2212 by 1659 pixels; color fundus image: 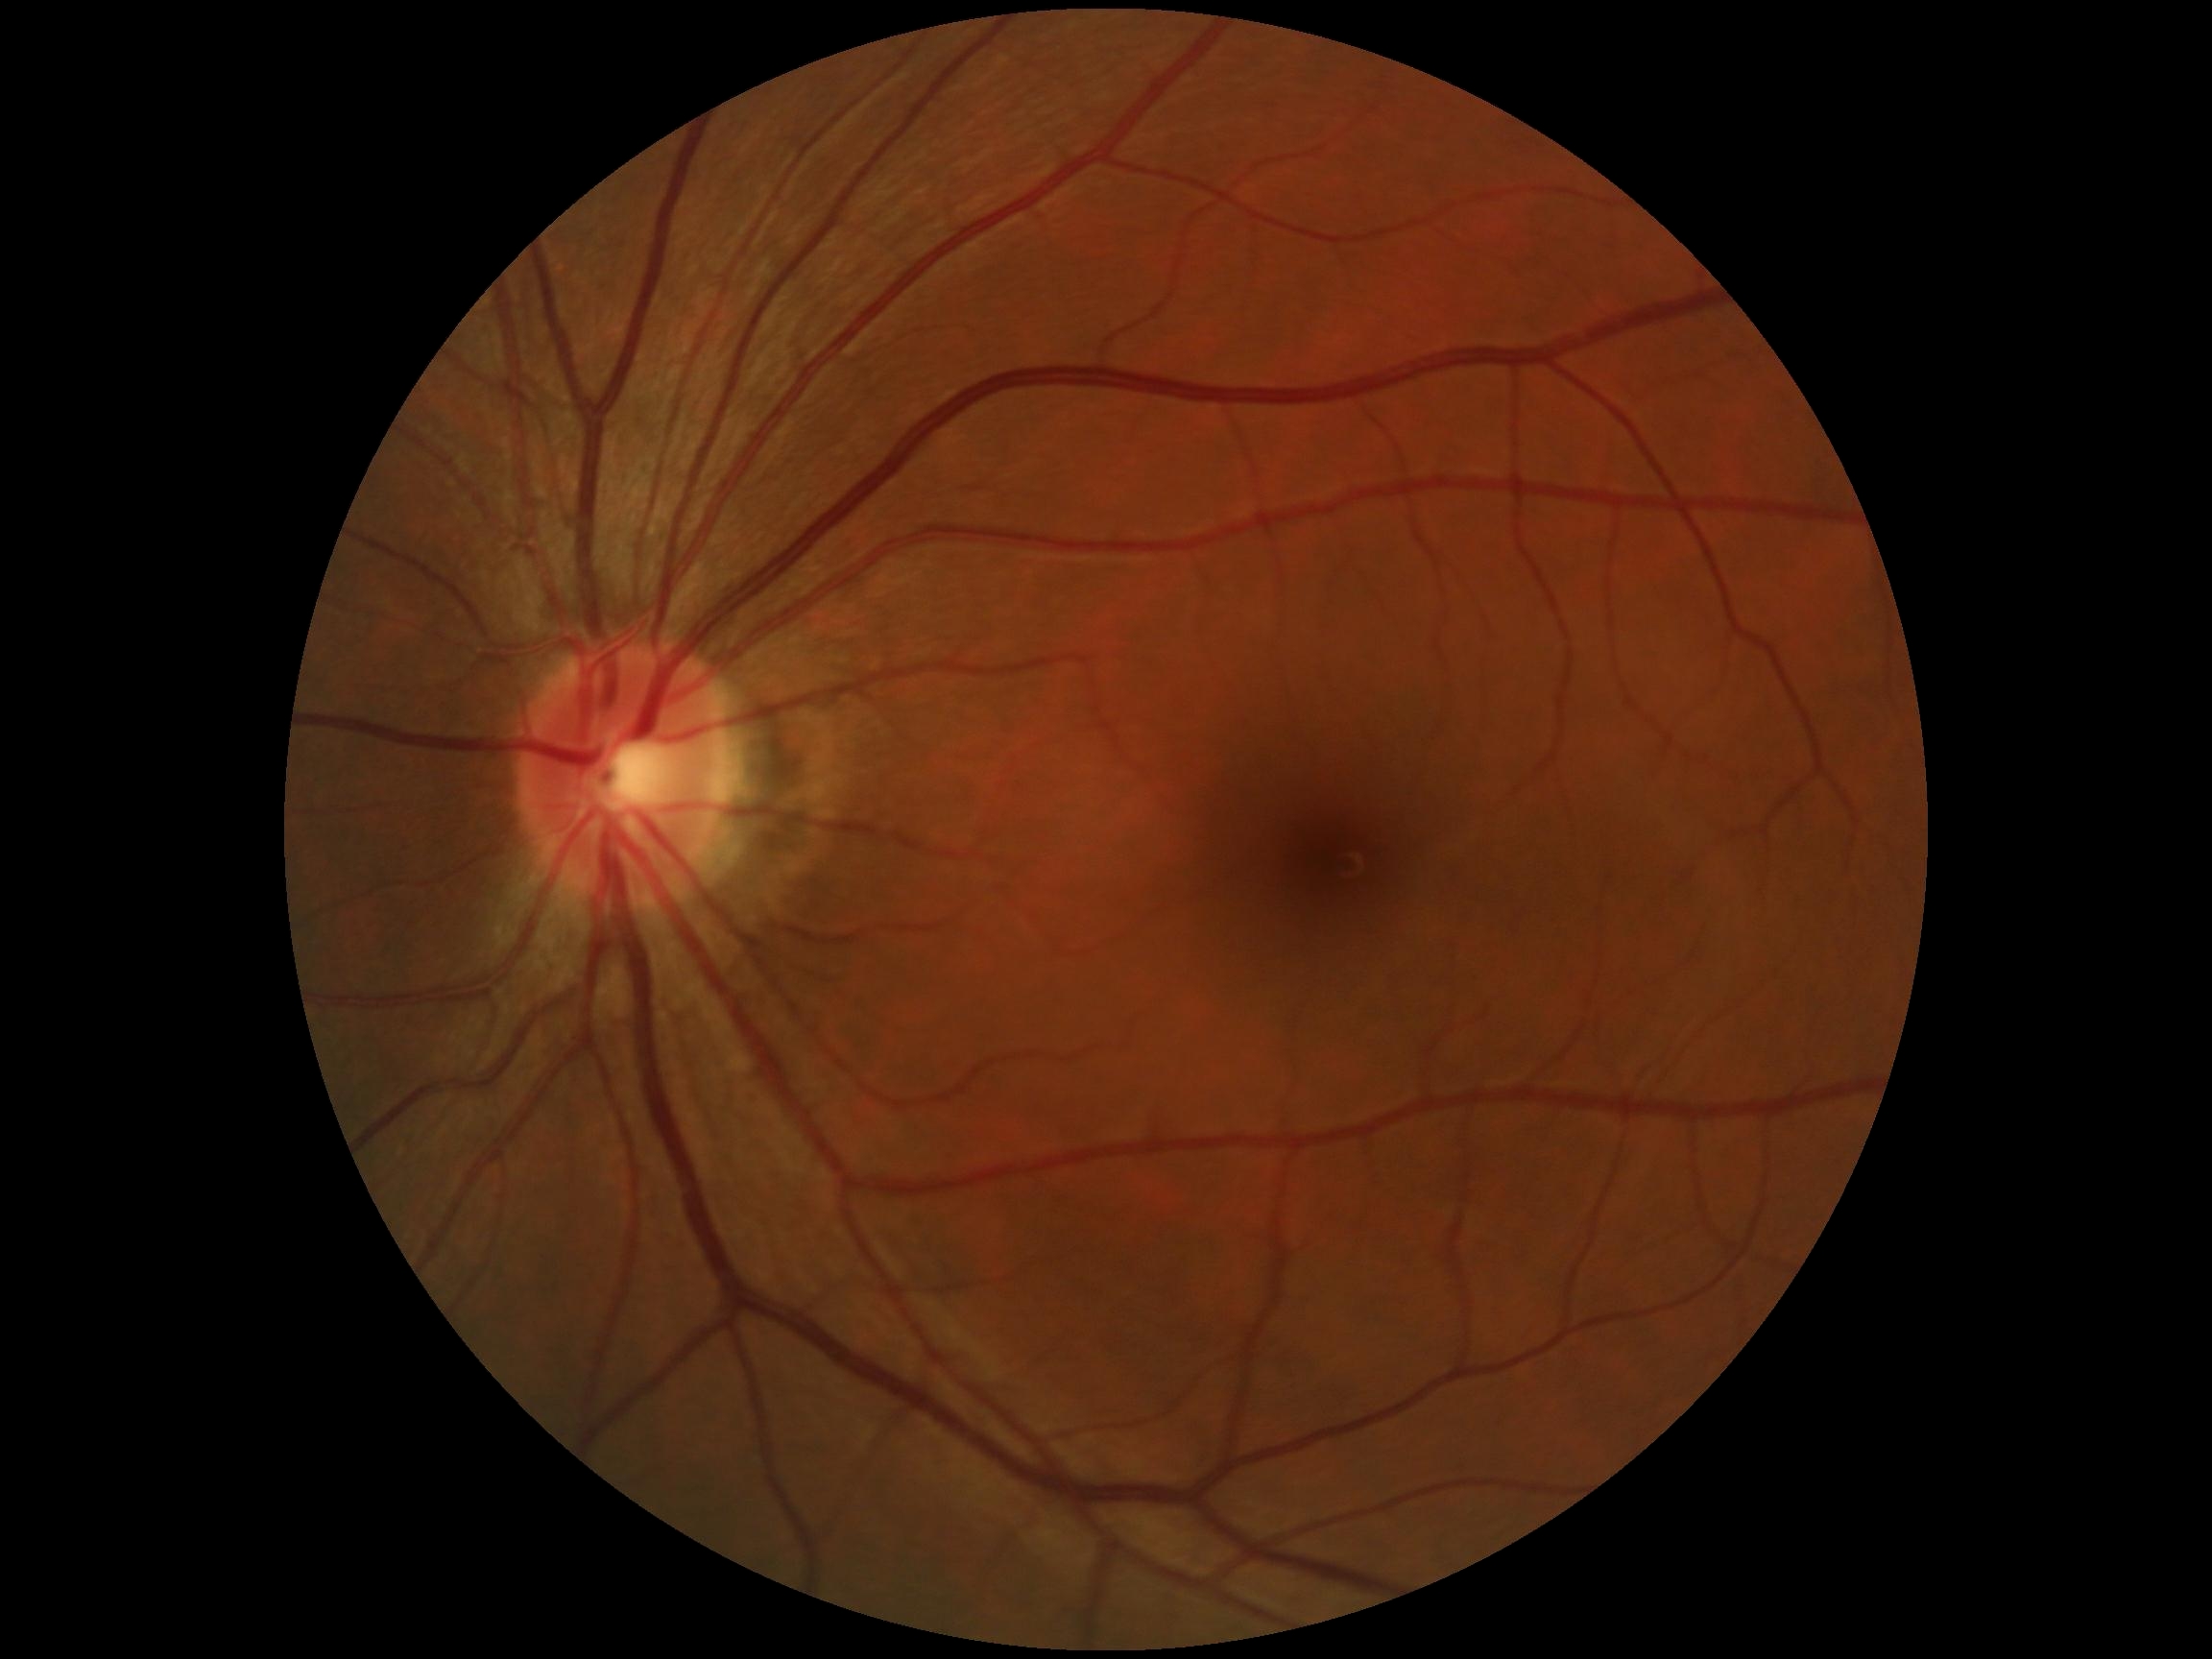
diabetic retinopathy grade: 0